Color fundus image.
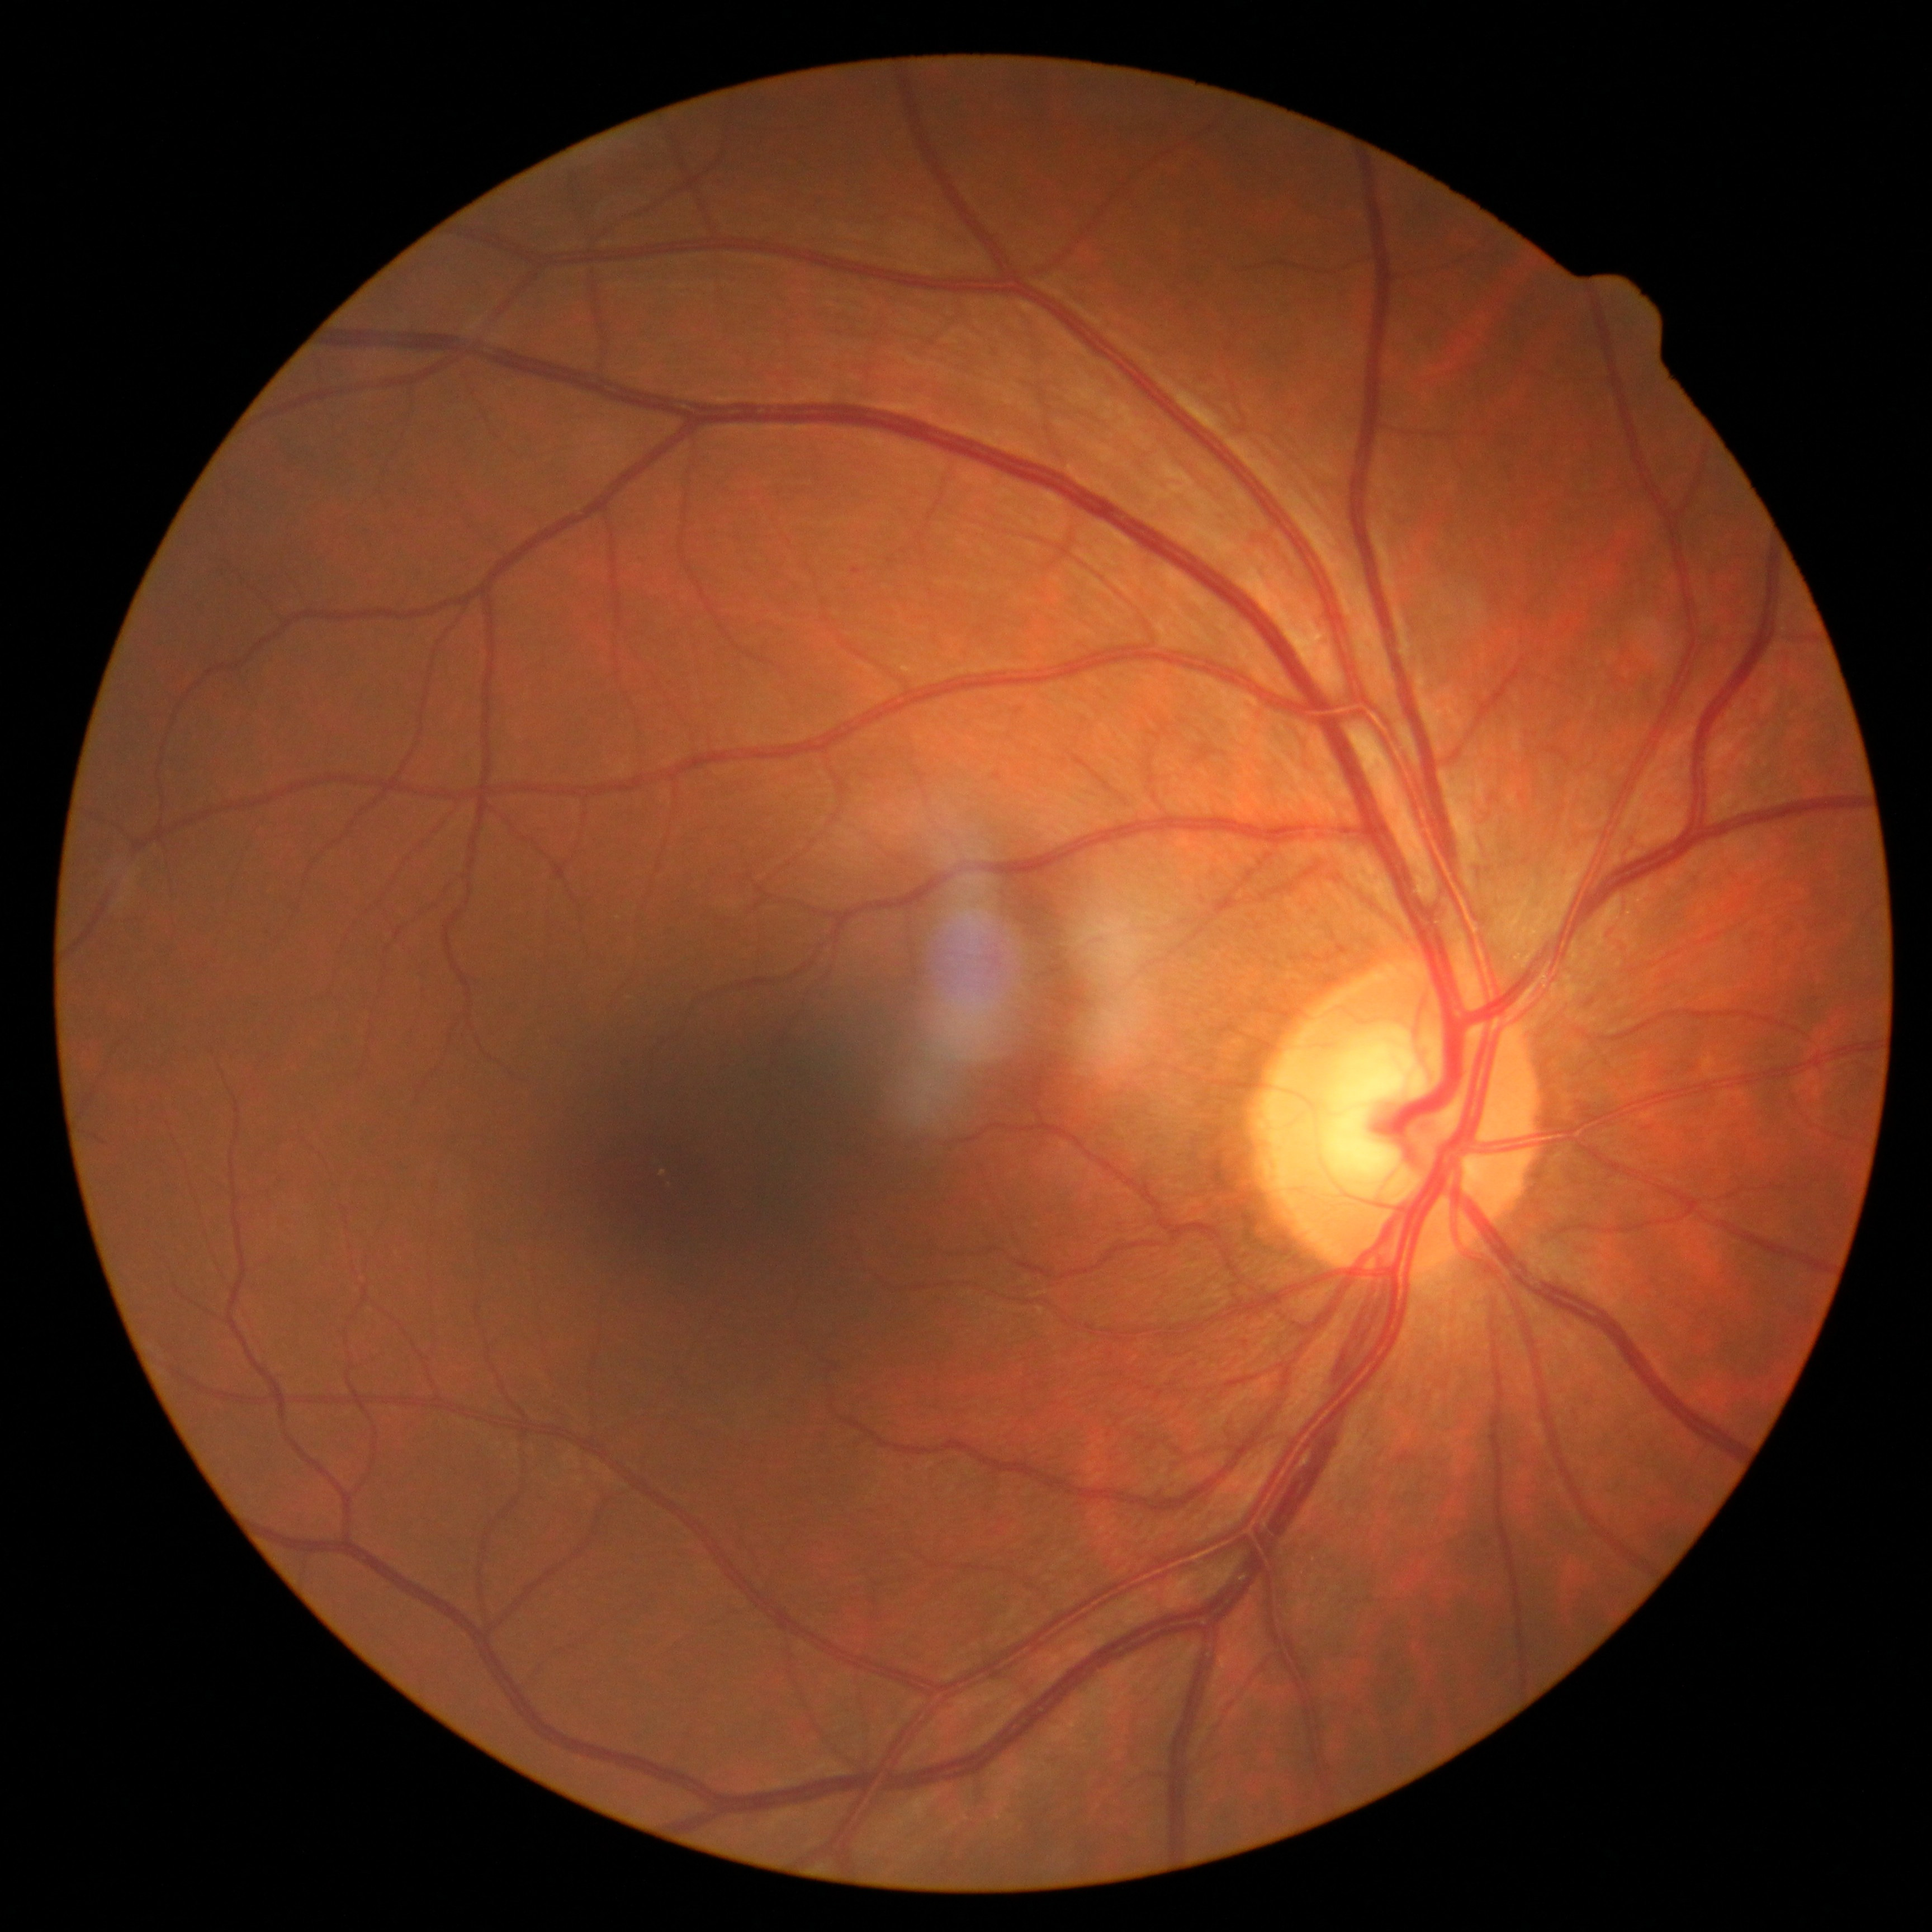 retinopathy: grade 1 (mild NPDR).